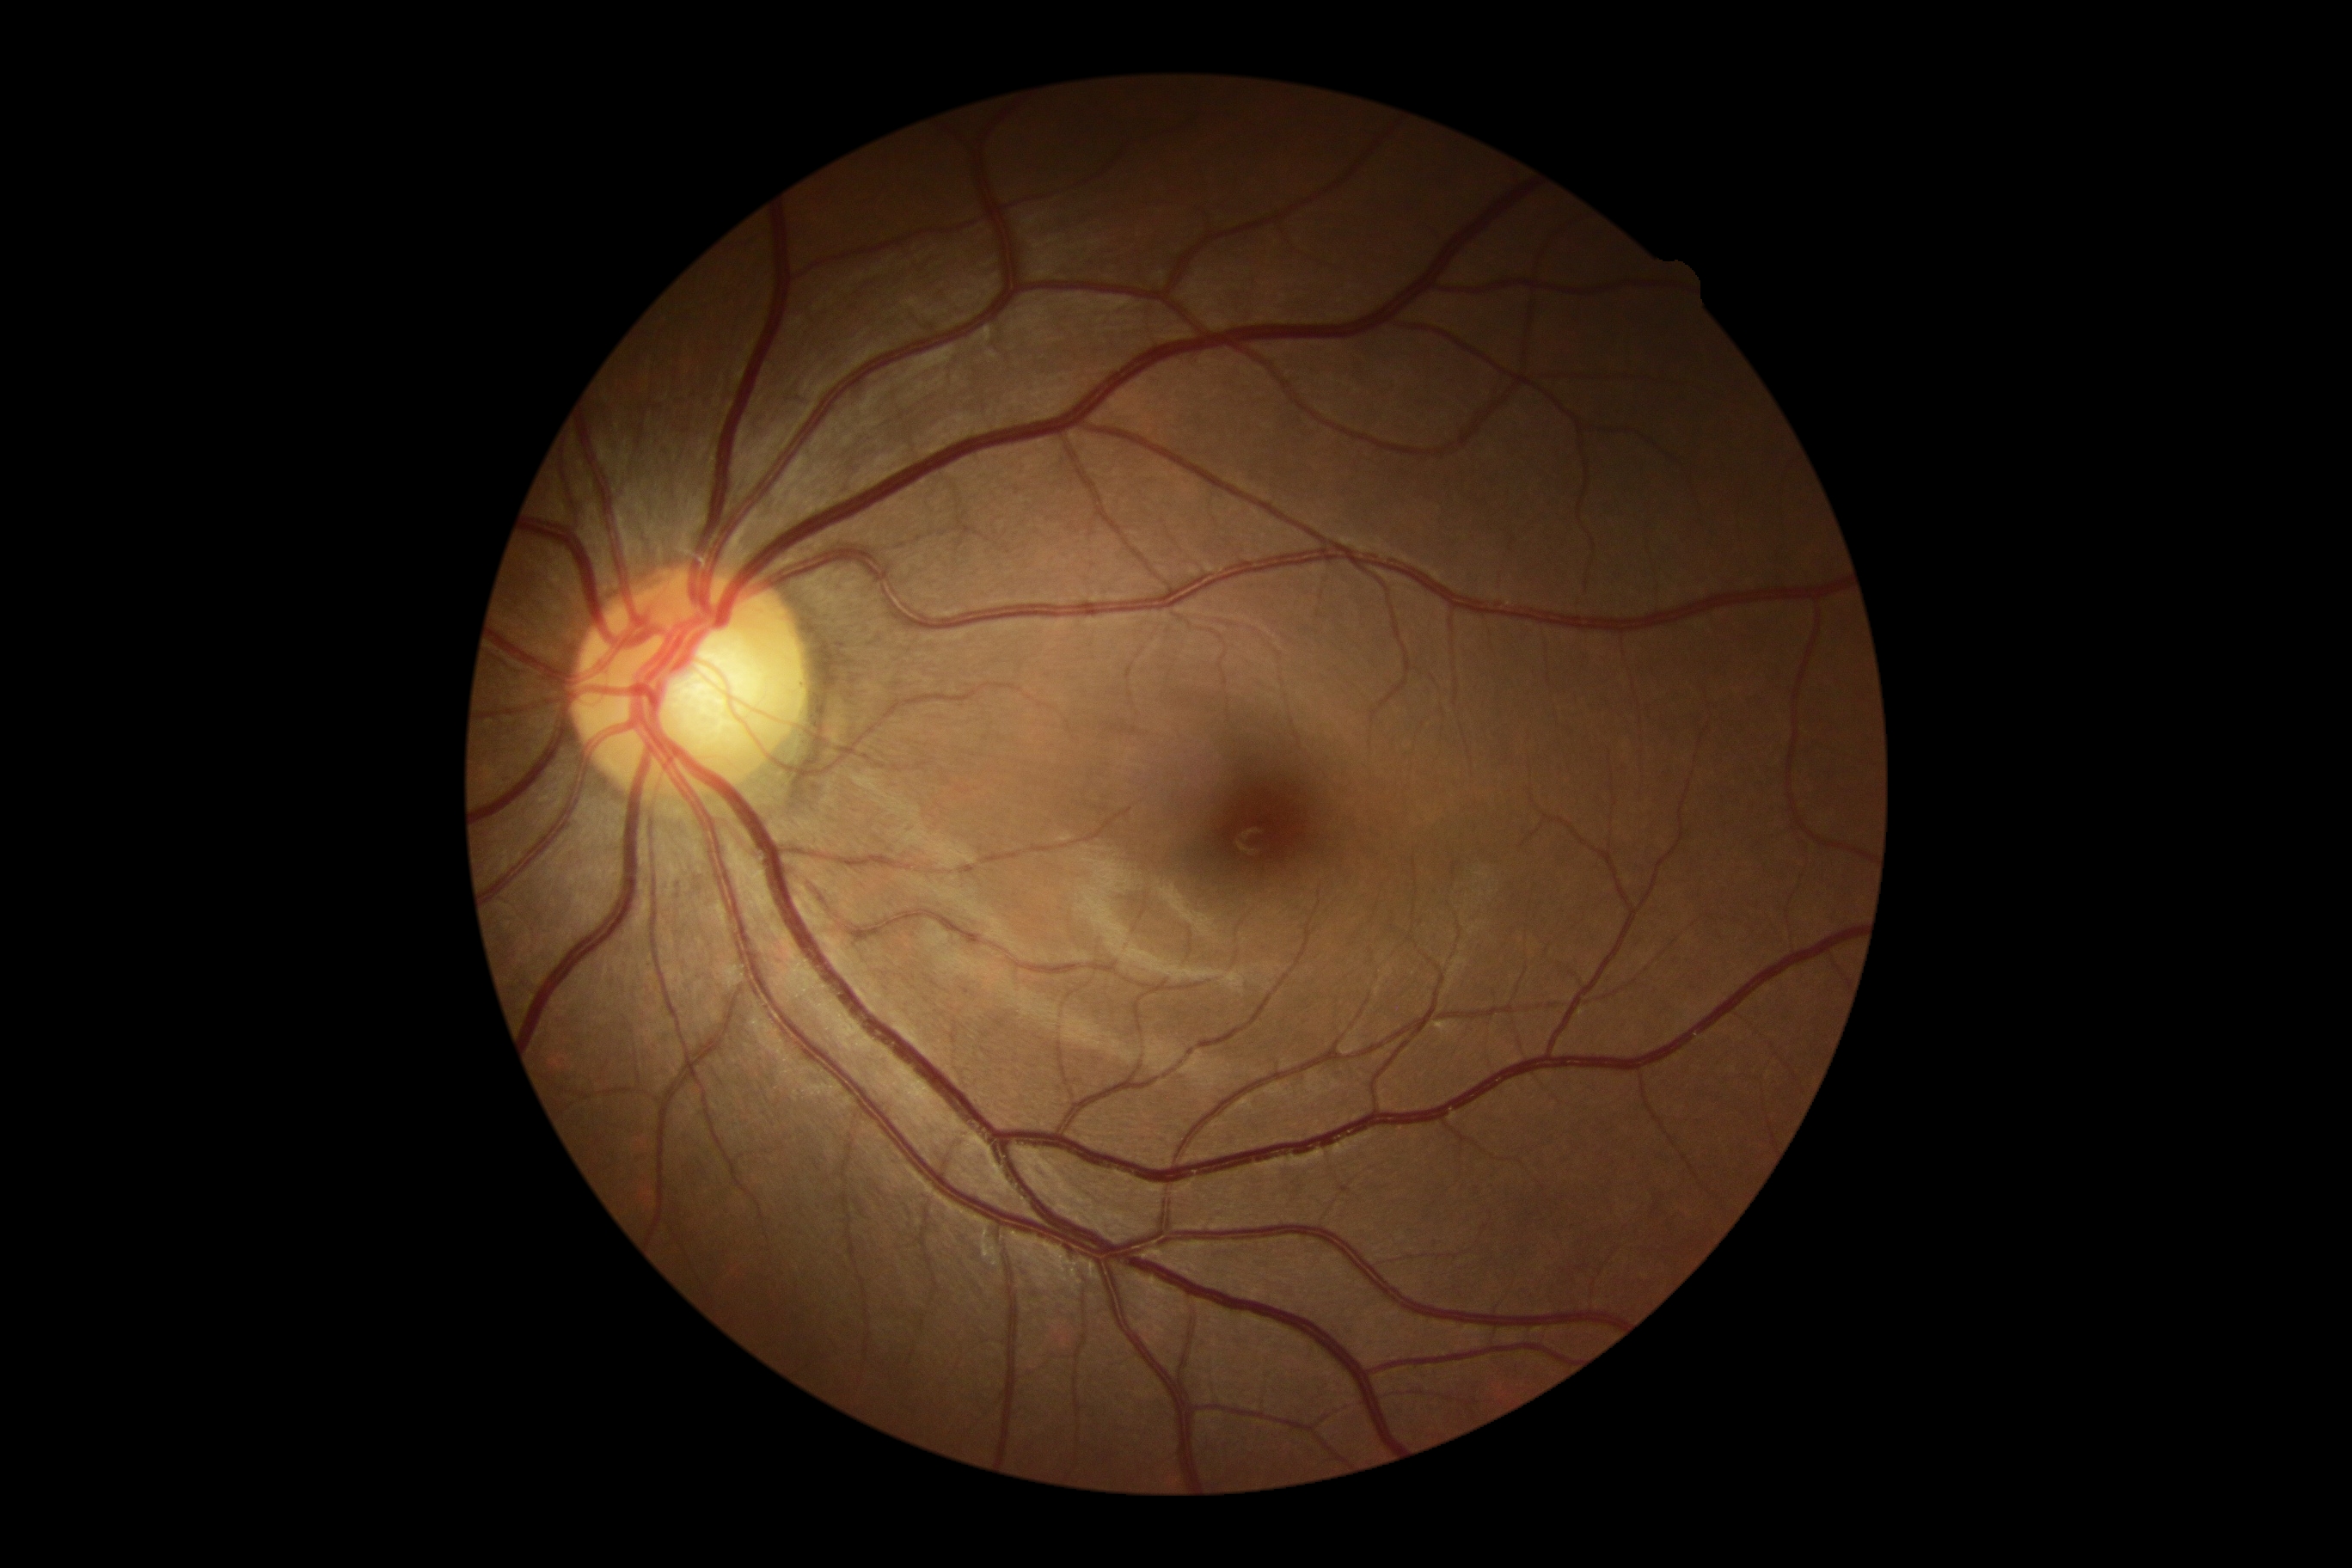

Retinopathy grade: no apparent retinopathy (0).